Image size 640x480; infant wide-field fundus photograph; 130° field of view (Clarity RetCam 3):
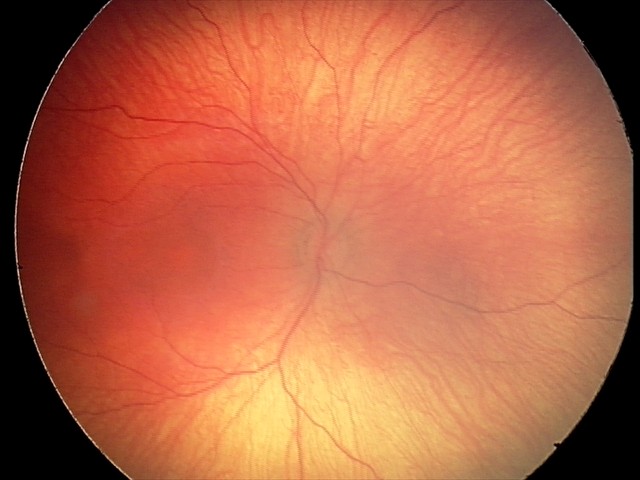
Examination with physiological retinal findings.